Posterior pole photograph: 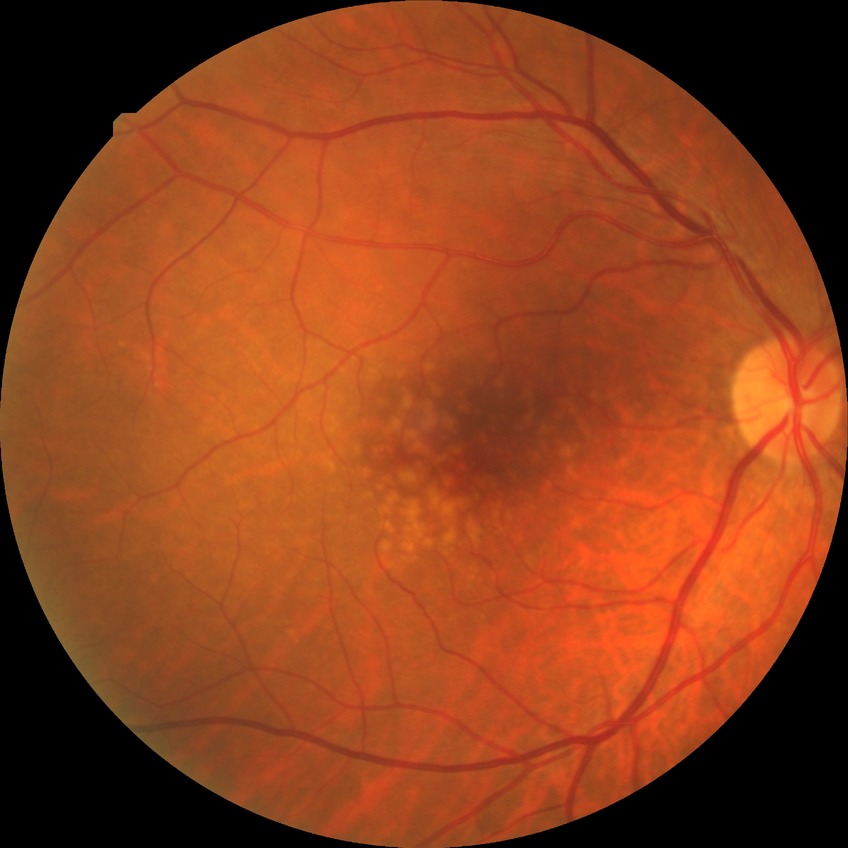
Diabetic retinopathy grade: no diabetic retinopathy.